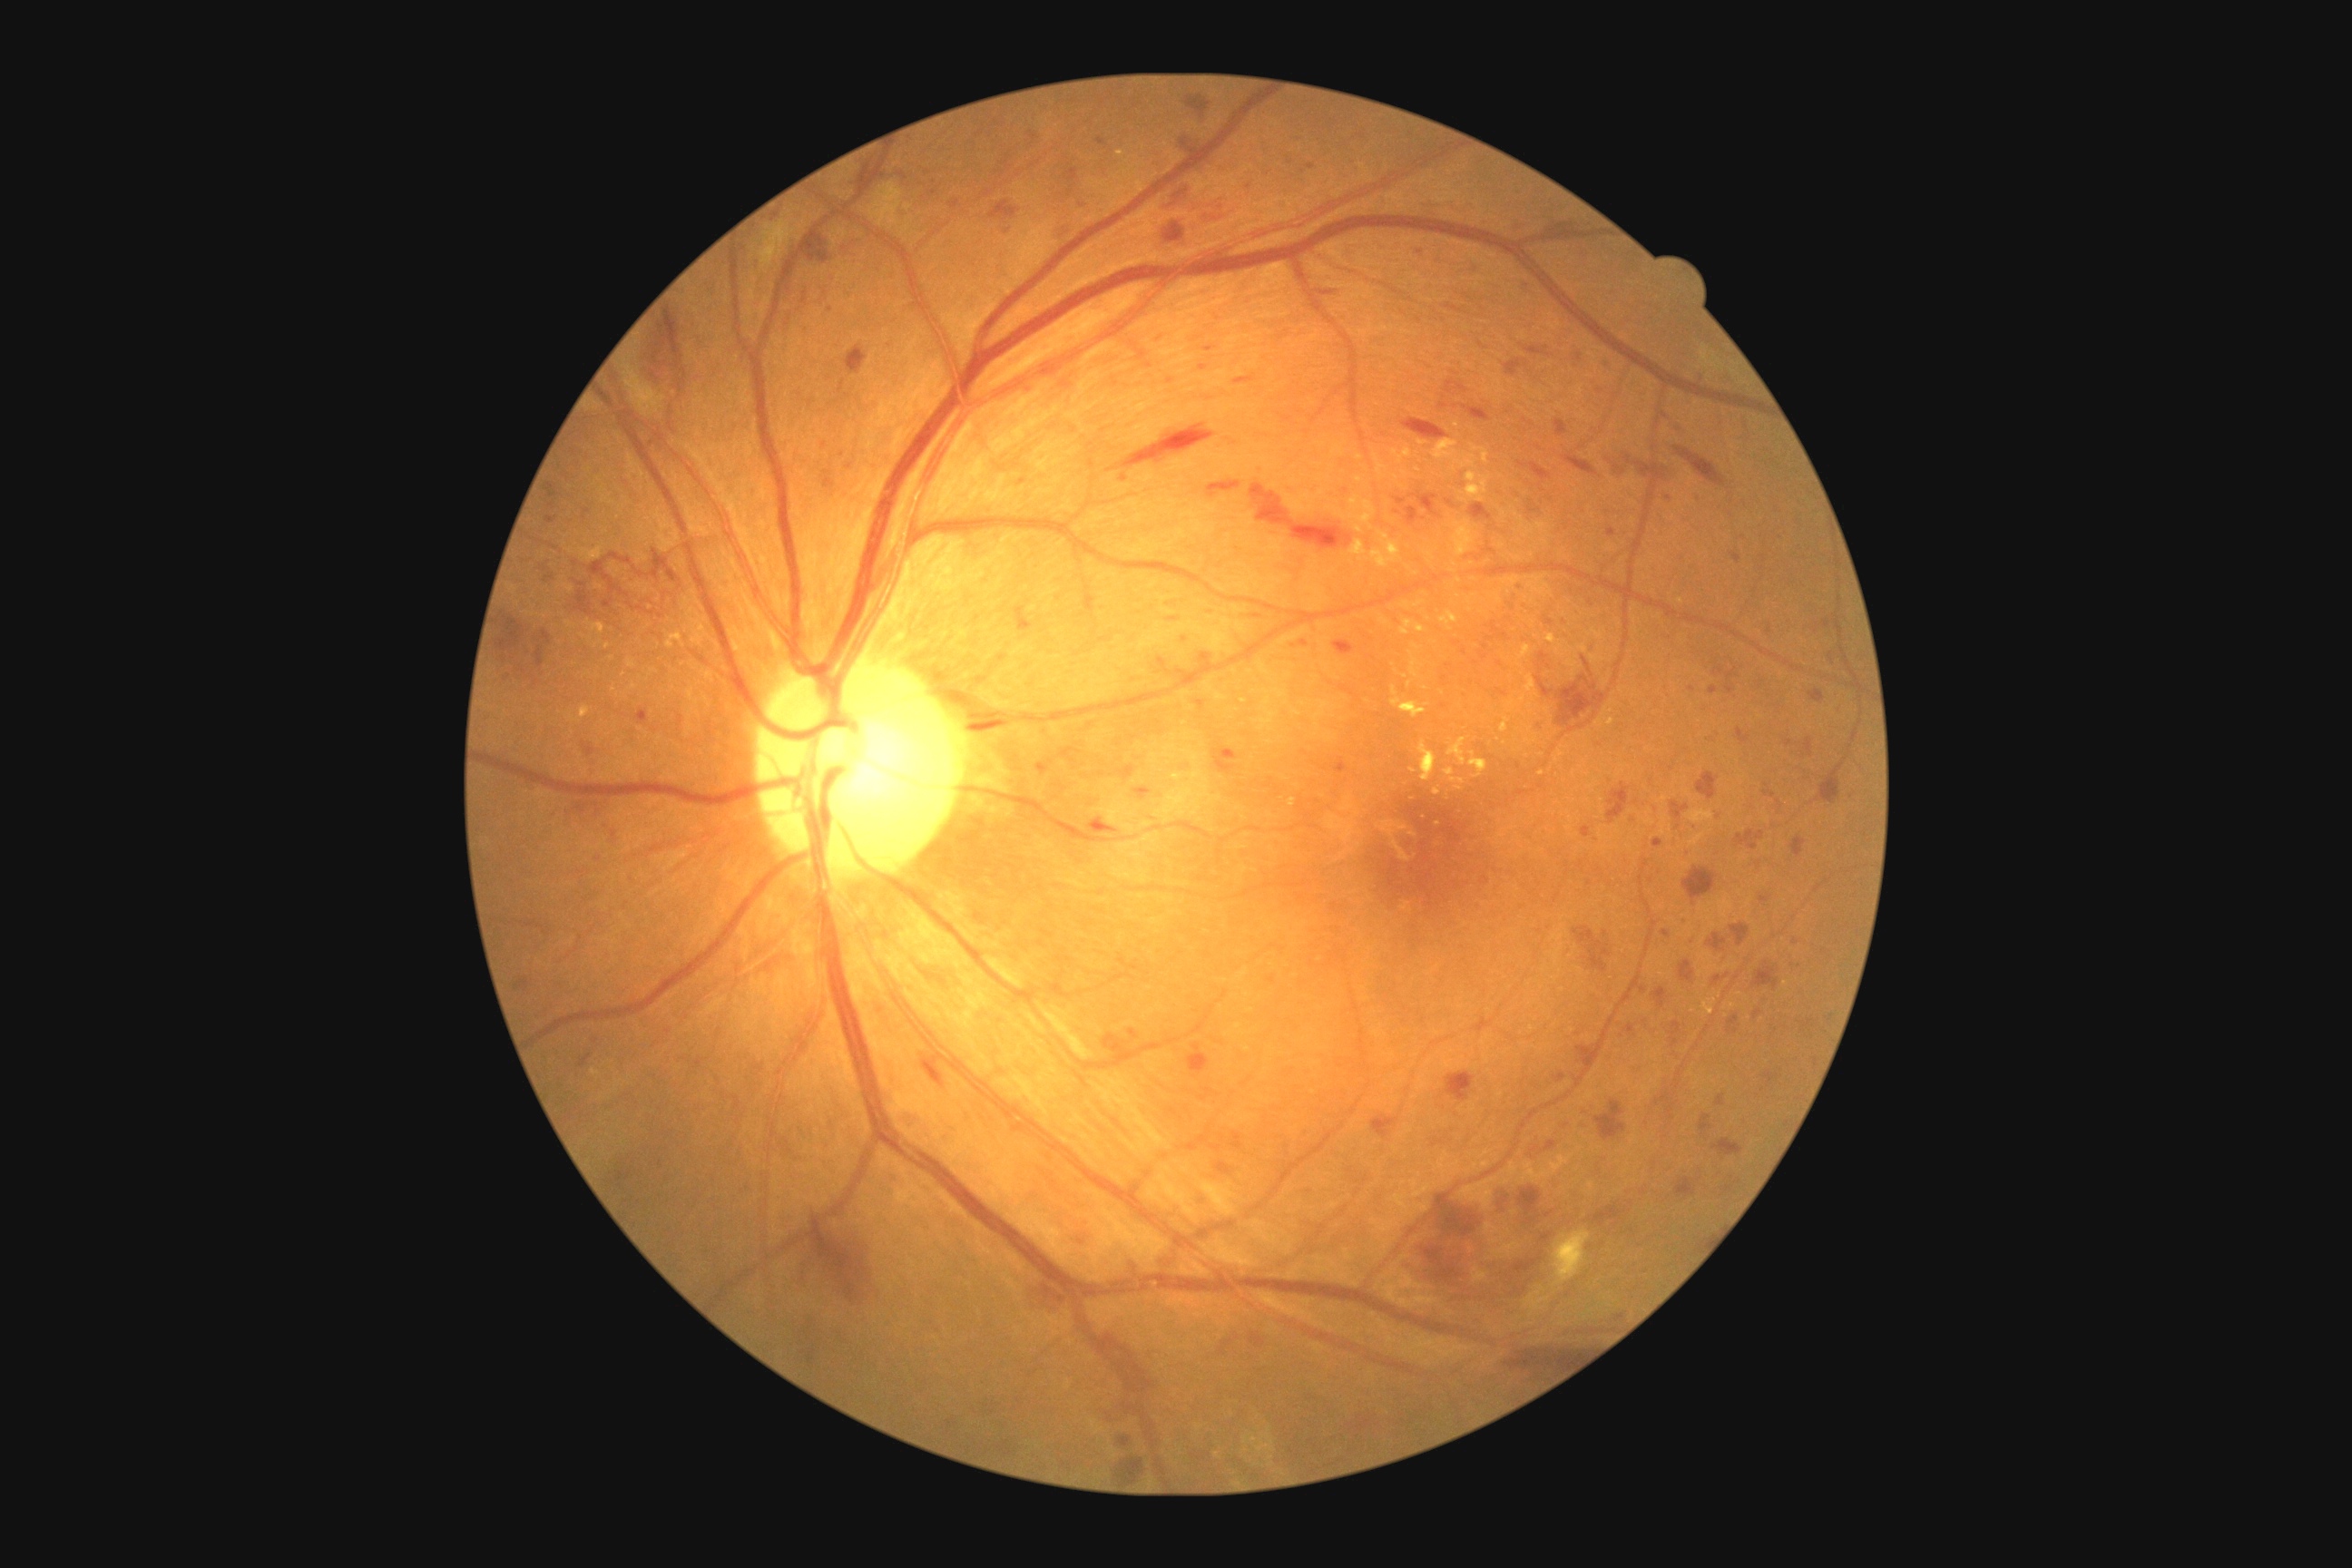
<lesions partial="true">
  <dr_grade>3</dr_grade>
  <he partial="true">region(1727, 669, 1738, 681) | region(1671, 801, 1689, 819) | region(1554, 420, 1567, 436) | region(1730, 925, 1750, 946) | region(1446, 500, 1455, 507) | region(1213, 747, 1237, 774) | region(1446, 1072, 1475, 1102) | region(1828, 652, 1834, 663) | region(1729, 1017, 1740, 1026) | region(1680, 961, 1696, 985) | region(1122, 424, 1215, 469) | region(1712, 1139, 1743, 1157) | region(1233, 375, 1257, 386) | region(1805, 738, 1814, 758) | region(823, 471, 836, 489) | region(1487, 1255, 1549, 1284) | region(1754, 963, 1779, 990) | region(1179, 137, 1200, 150) | region(1716, 1095, 1727, 1106)</he>
  <he_small_approx>x=1769, y=630</he_small_approx>
  <ma partial="true">region(1725, 685, 1734, 694) | region(1288, 1142, 1291, 1150) | region(1554, 1073, 1565, 1083) | region(1603, 358, 1611, 368) | region(603, 600, 612, 609) | region(1685, 917, 1690, 925) | region(1200, 364, 1208, 371) | region(1640, 986, 1649, 990) | region(1155, 658, 1168, 667) | region(1750, 830, 1758, 838)</ma>
  <ma_small_approx>x=1171, y=381 | x=596, y=1042 | x=934, y=194 | x=1294, y=647 | x=1351, y=1170 | x=1589, y=884</ma_small_approx>
</lesions>